CFP: 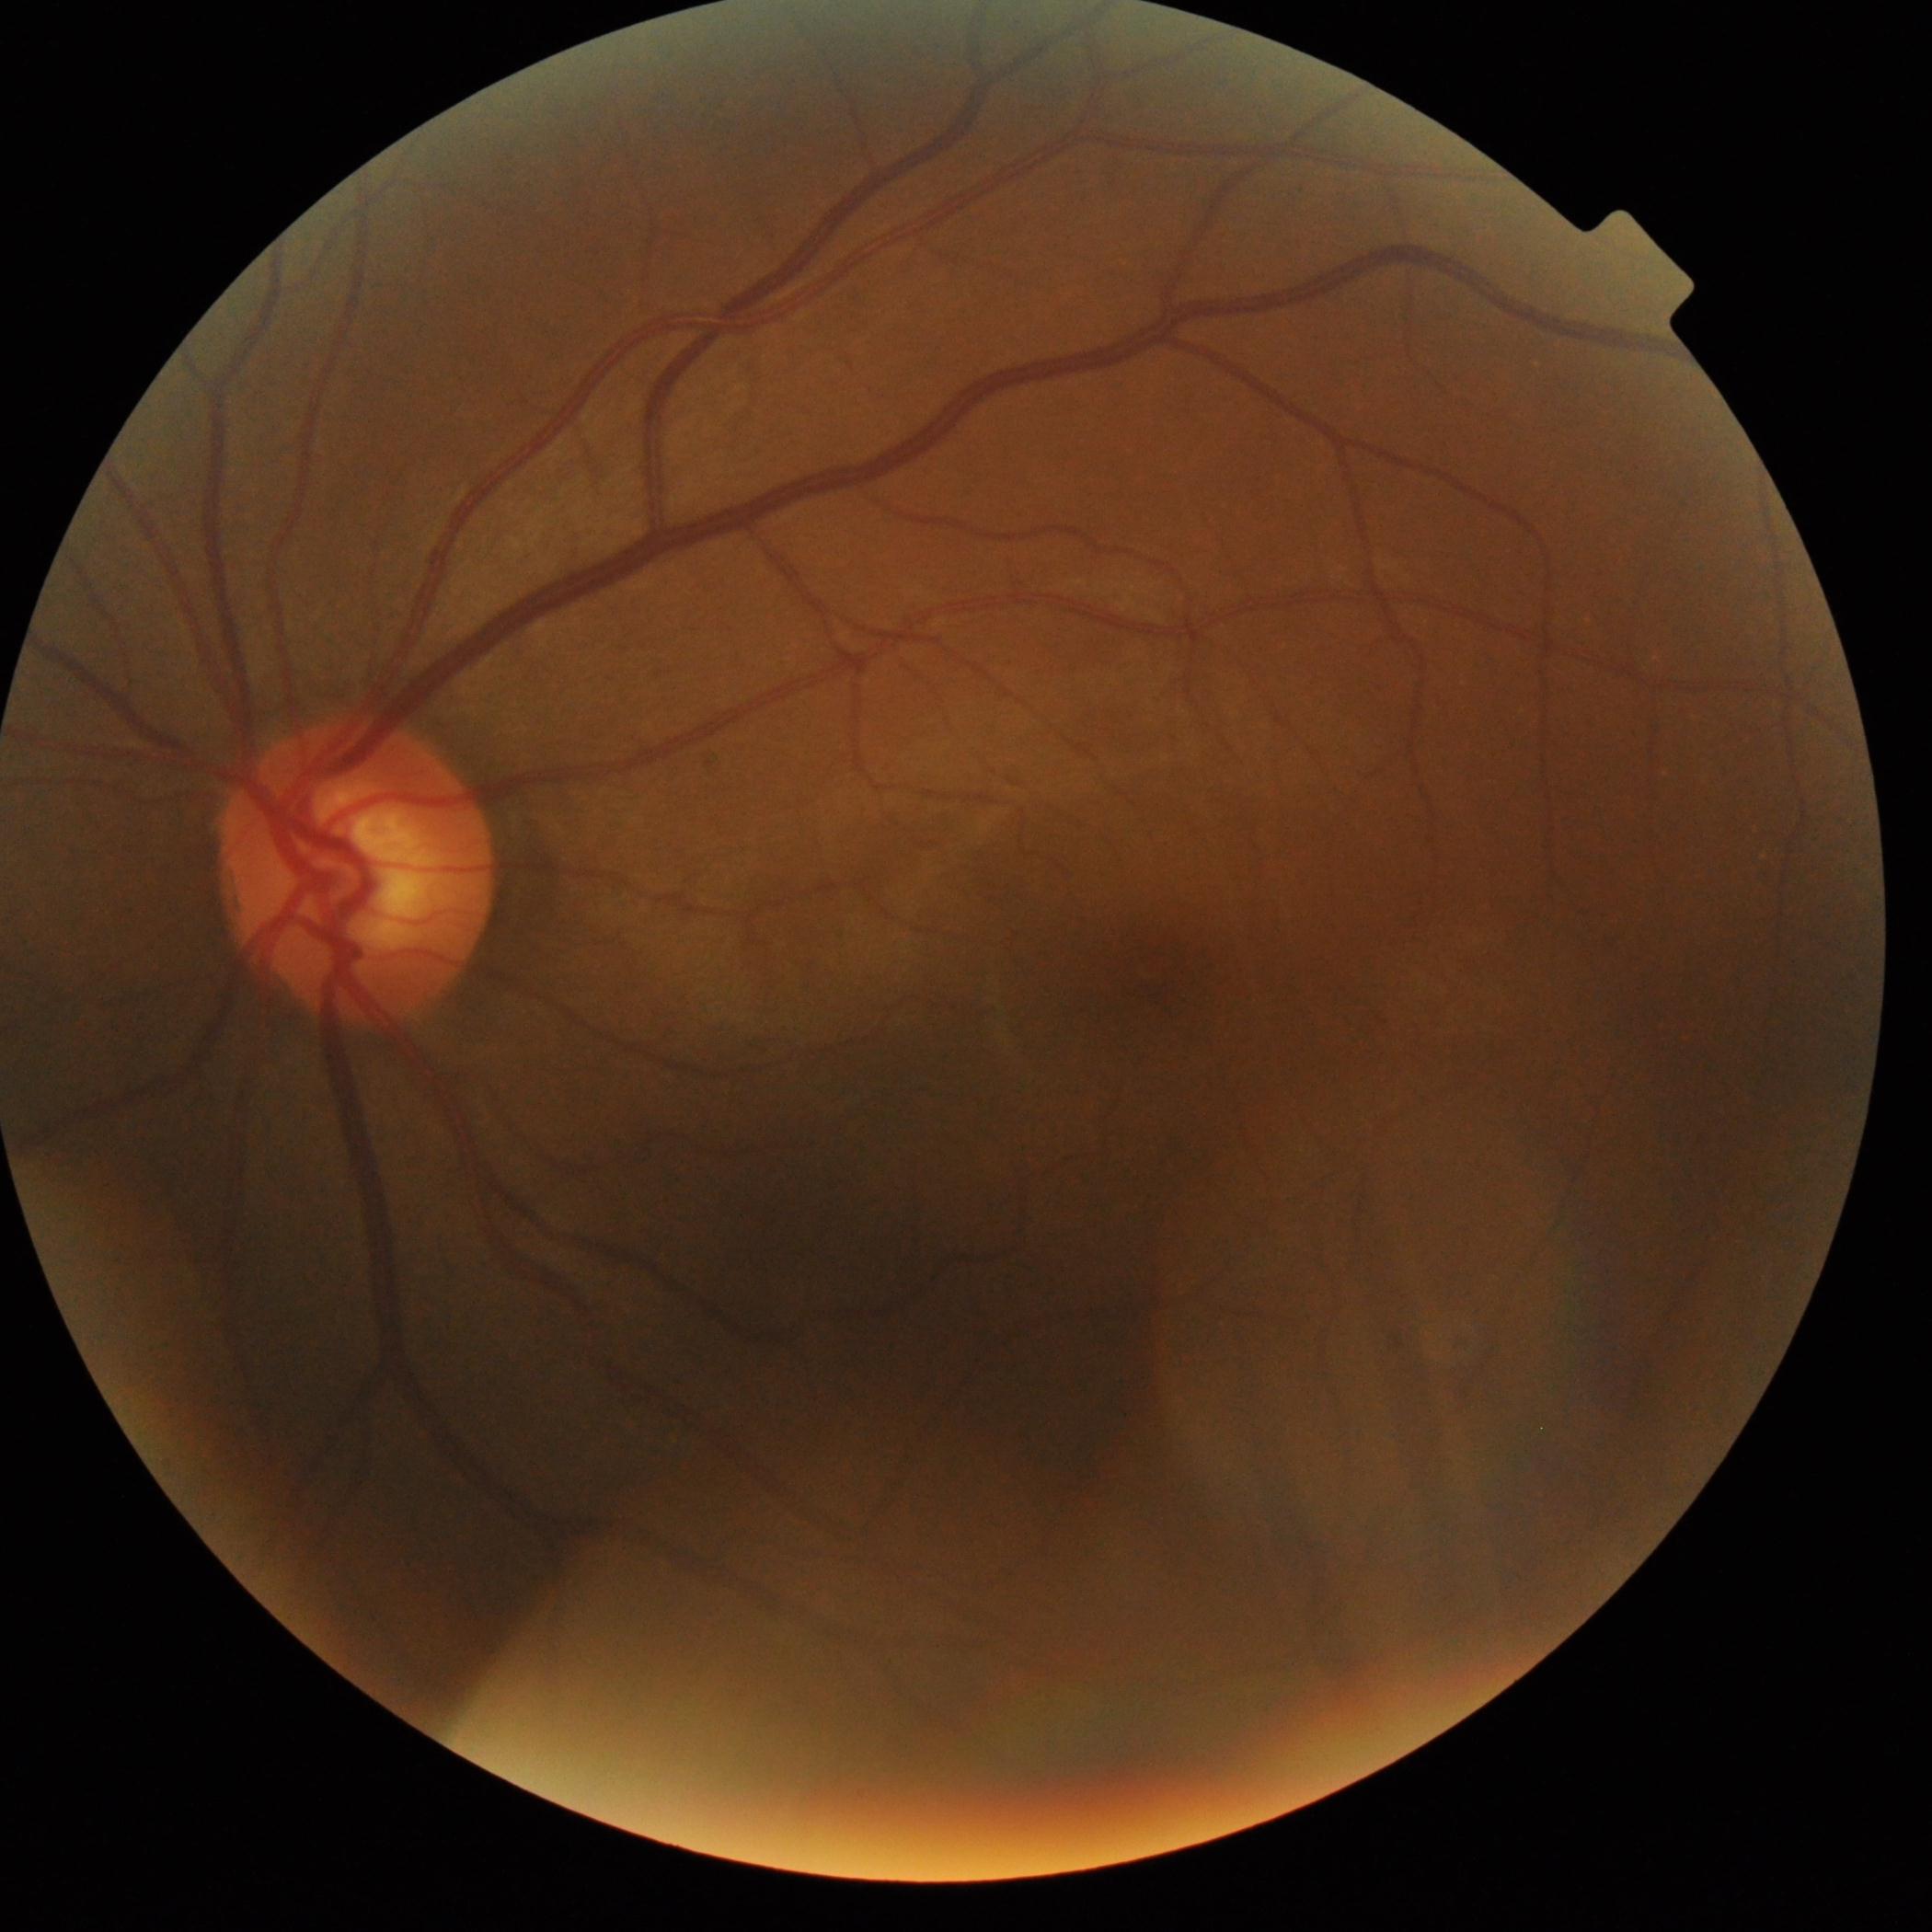

No DR findings.
Diabetic retinopathy: no apparent retinopathy (grade 0).